Wide-field contact fundus photograph of an infant · 130° field of view (Clarity RetCam 3) · image size 640x480: 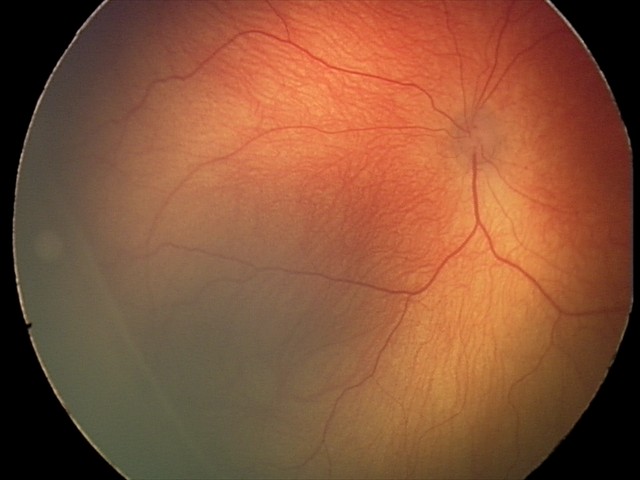 Impression: retinopathy of prematurity stage 2.